640 by 480 pixels; pediatric retinal photograph (wide-field) — 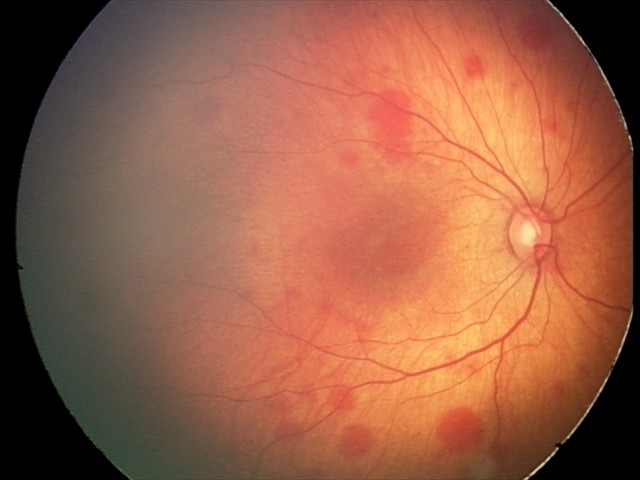
Assessment: retinal hemorrhages.